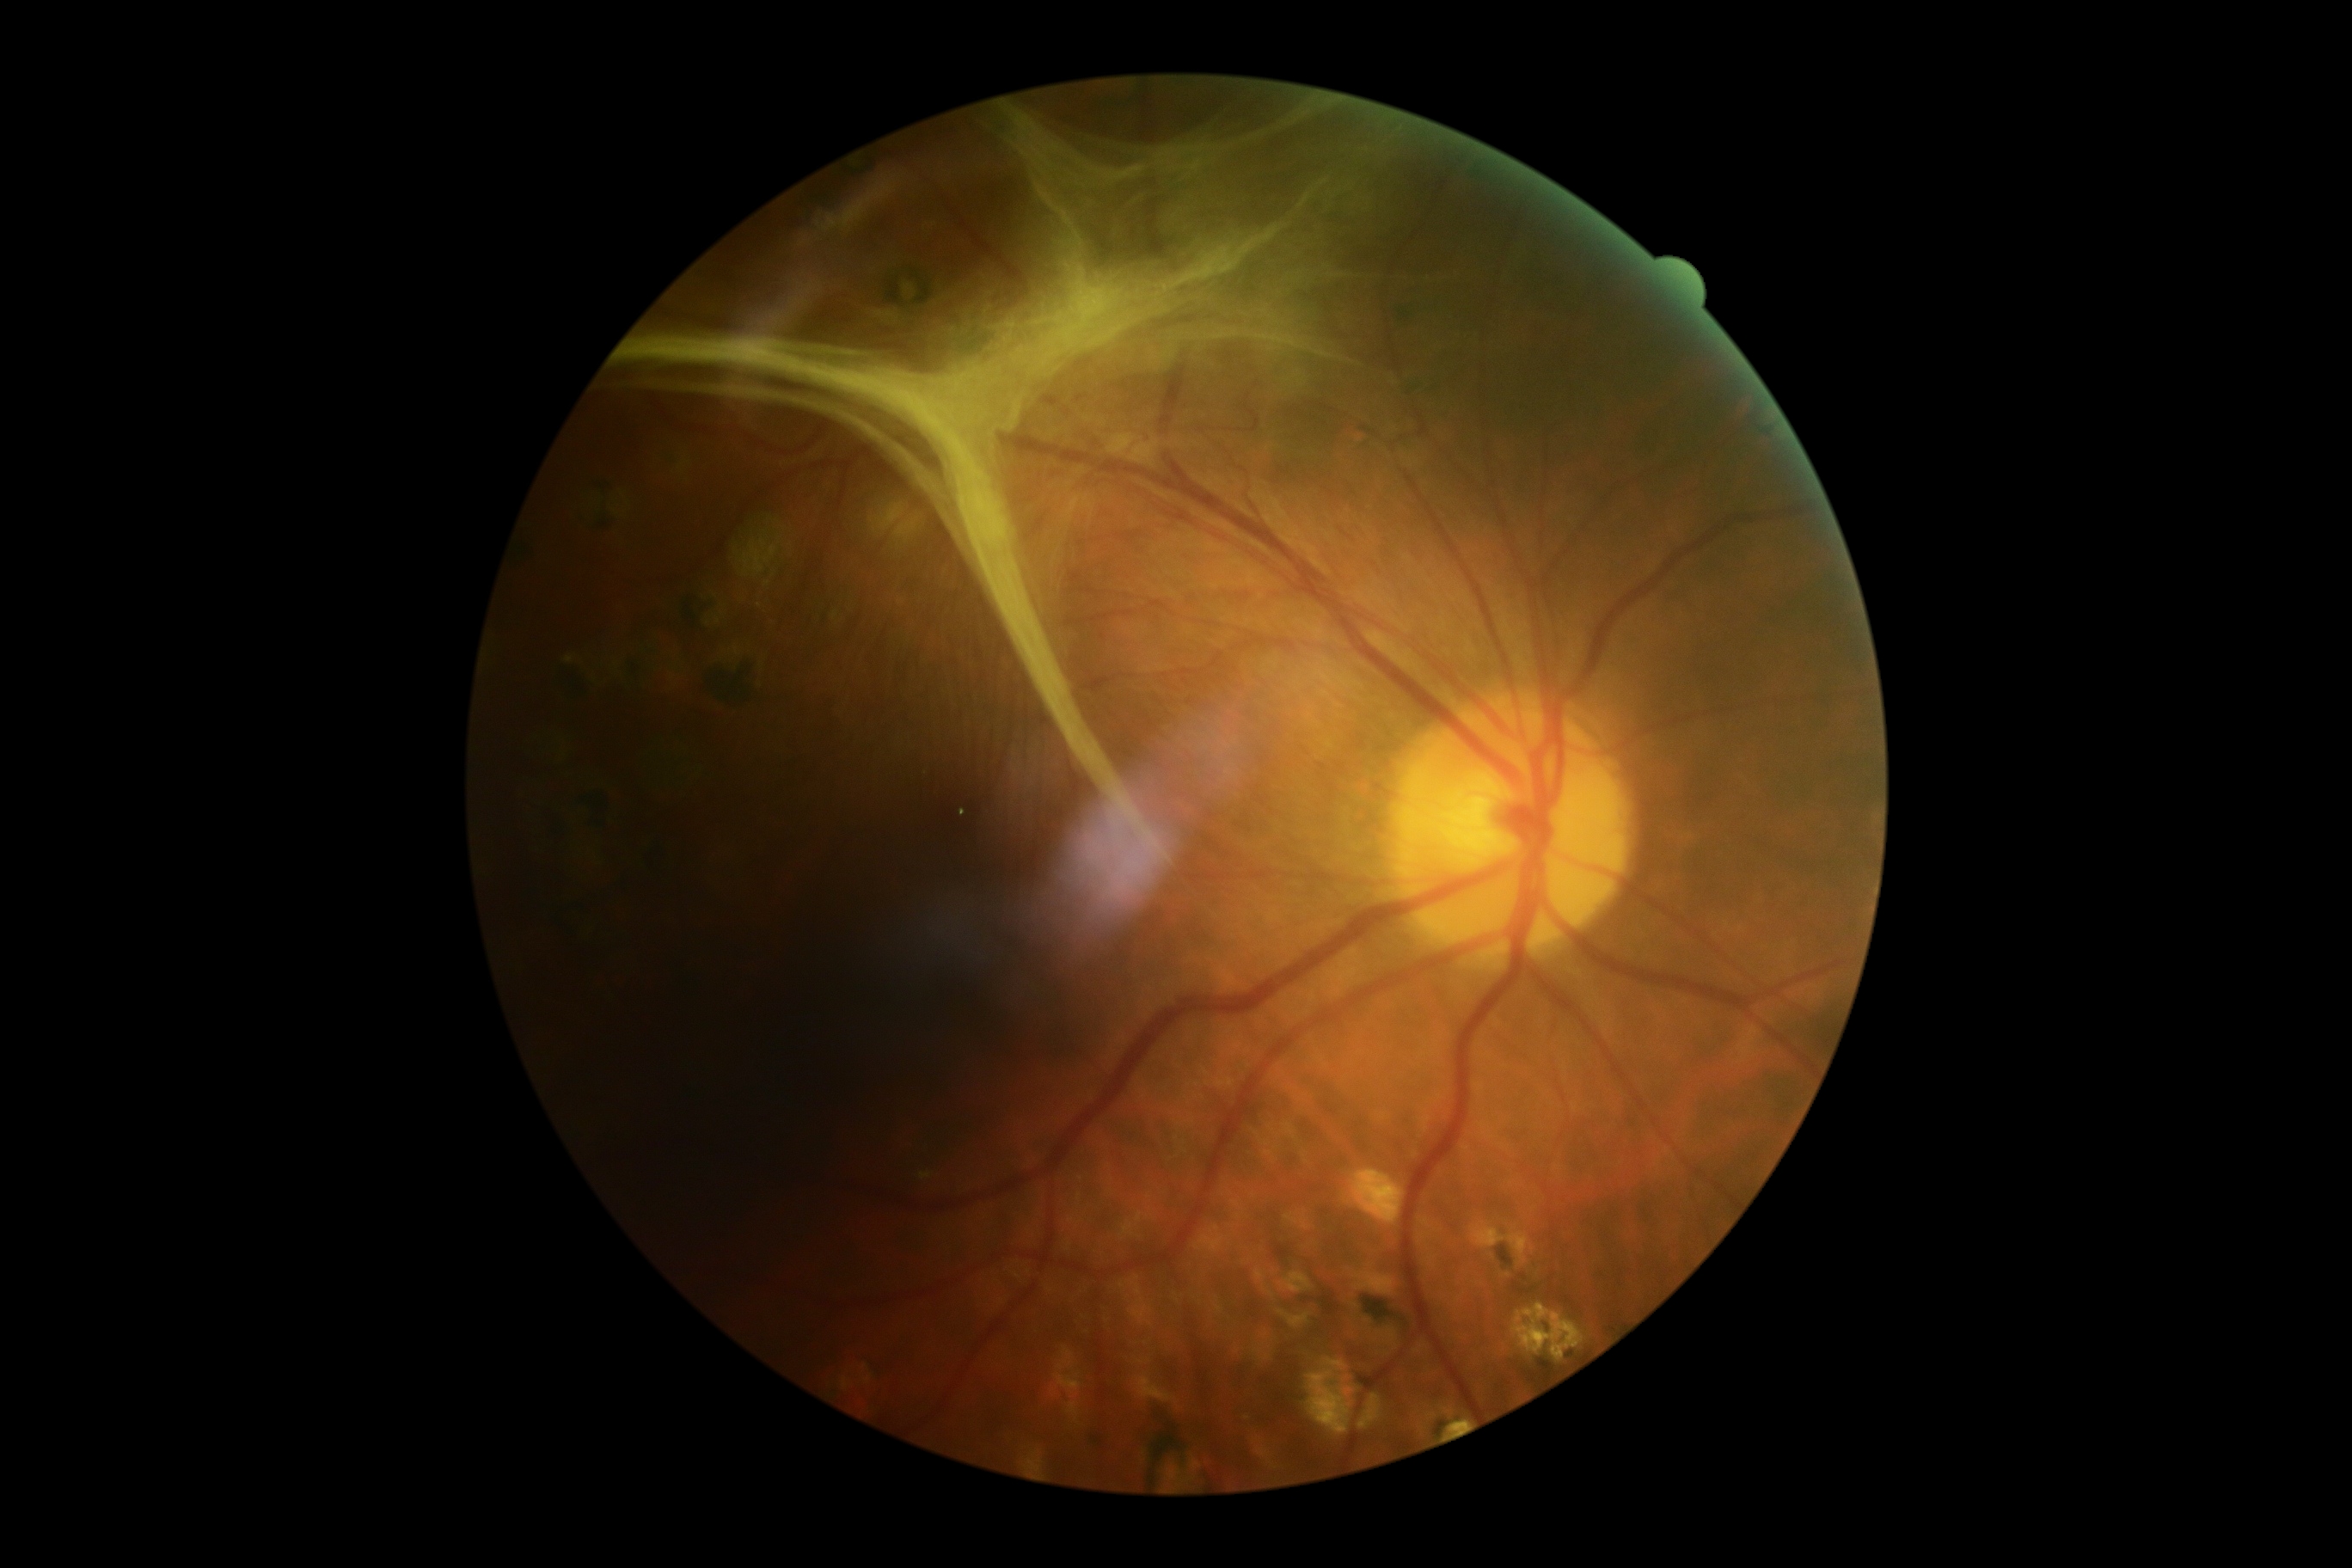 Diabetic retinopathy (DR) is grade 4.